Optic disc region of a color fundus photo · image size 619x571 — 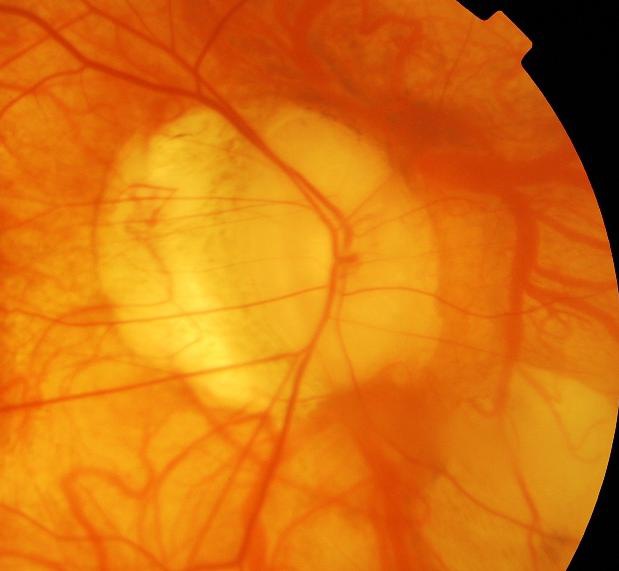
Q: Glaucoma assessment?
A: Glaucomatous changes.